Wide-field contact fundus photograph of an infant · 1240 x 1240 pixels
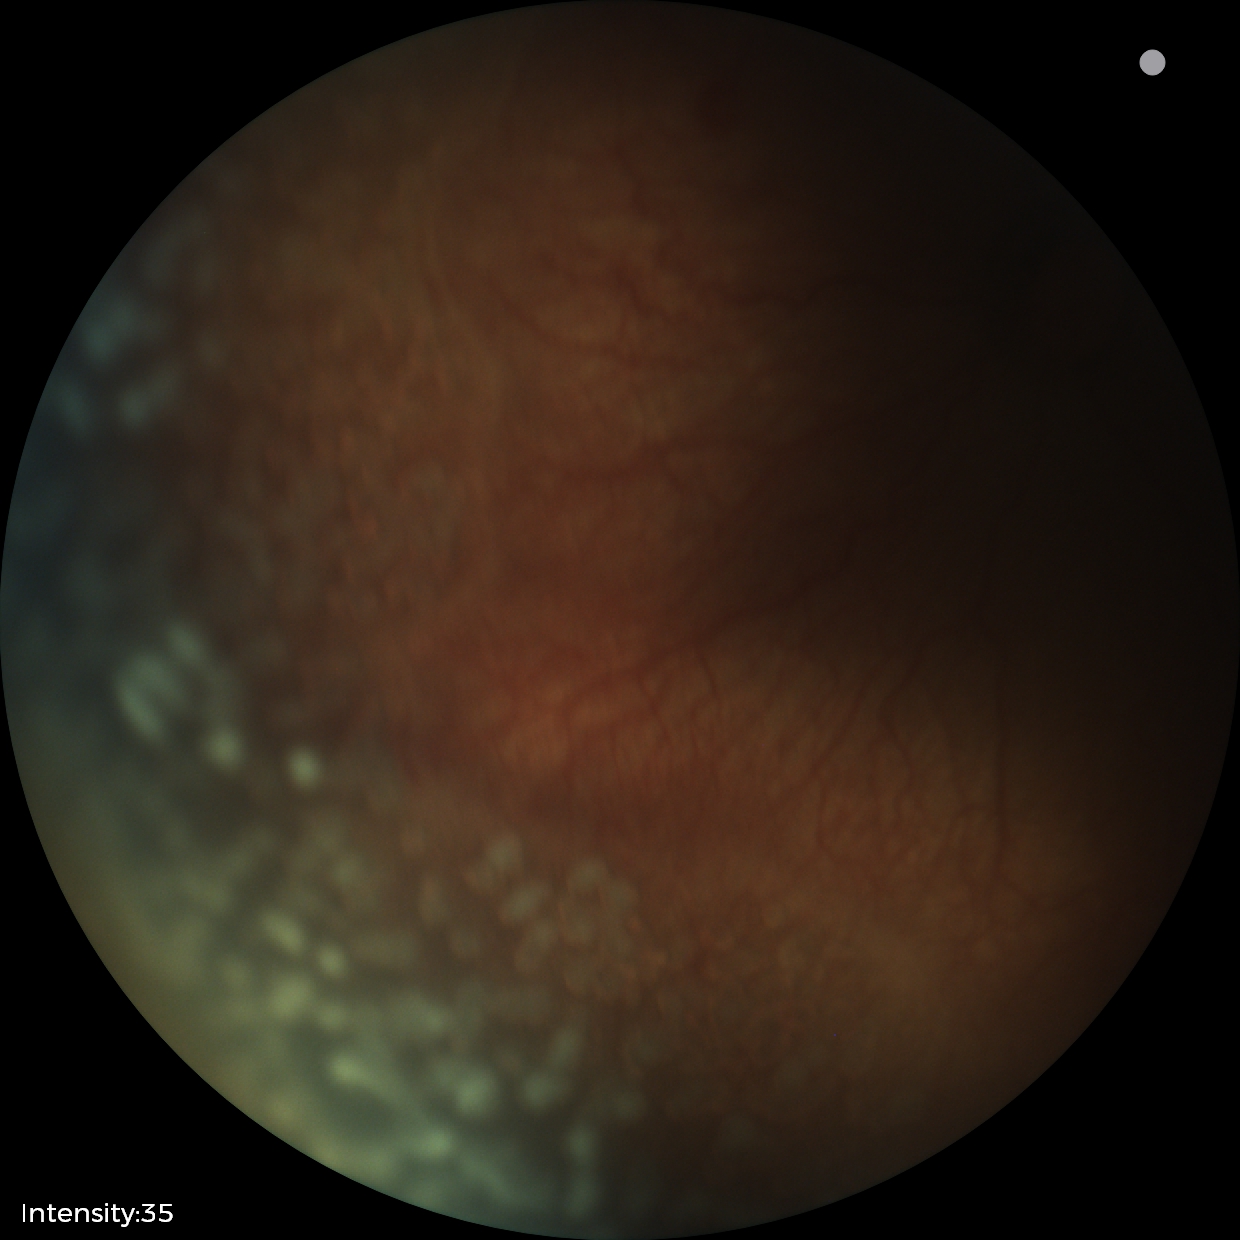

Plus disease present.
Series diagnosed as ROP stage 2.